2352x1568. Fundus photo. 45-degree field of view — 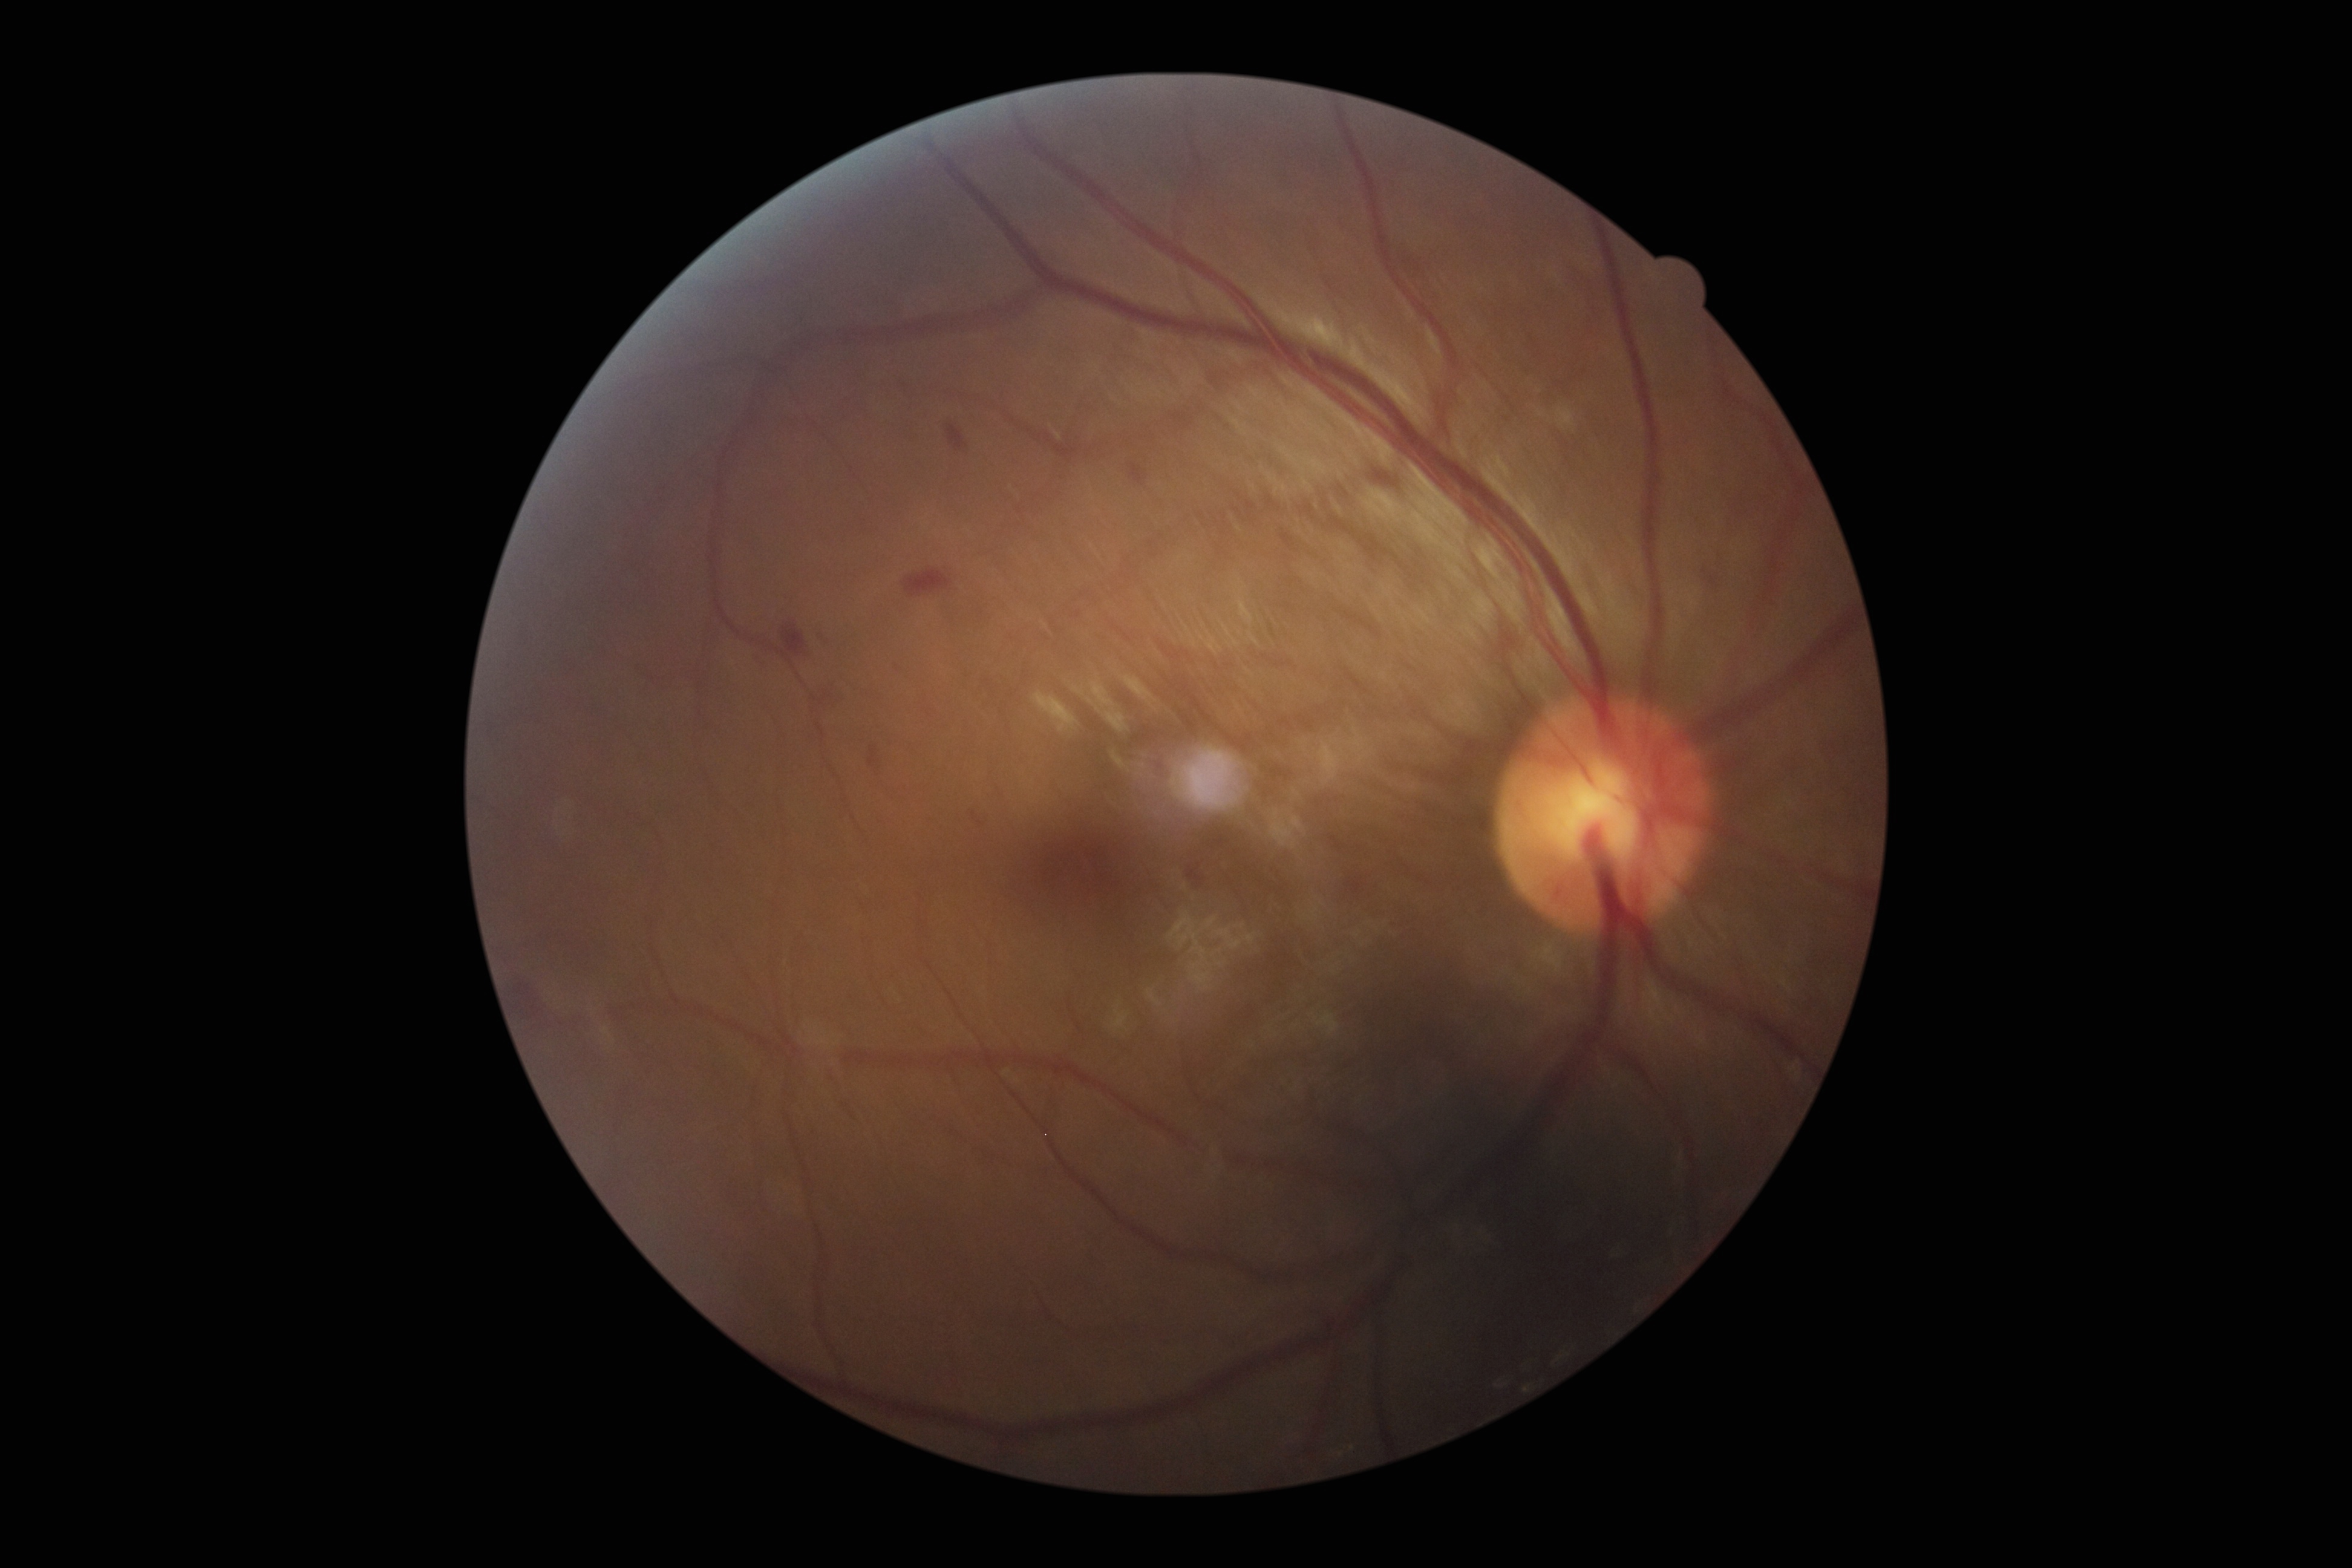

{"dr_grade": "moderate NPDR (2)"}